Acquired on the Phoenix ICON; pediatric wide-field fundus photograph:
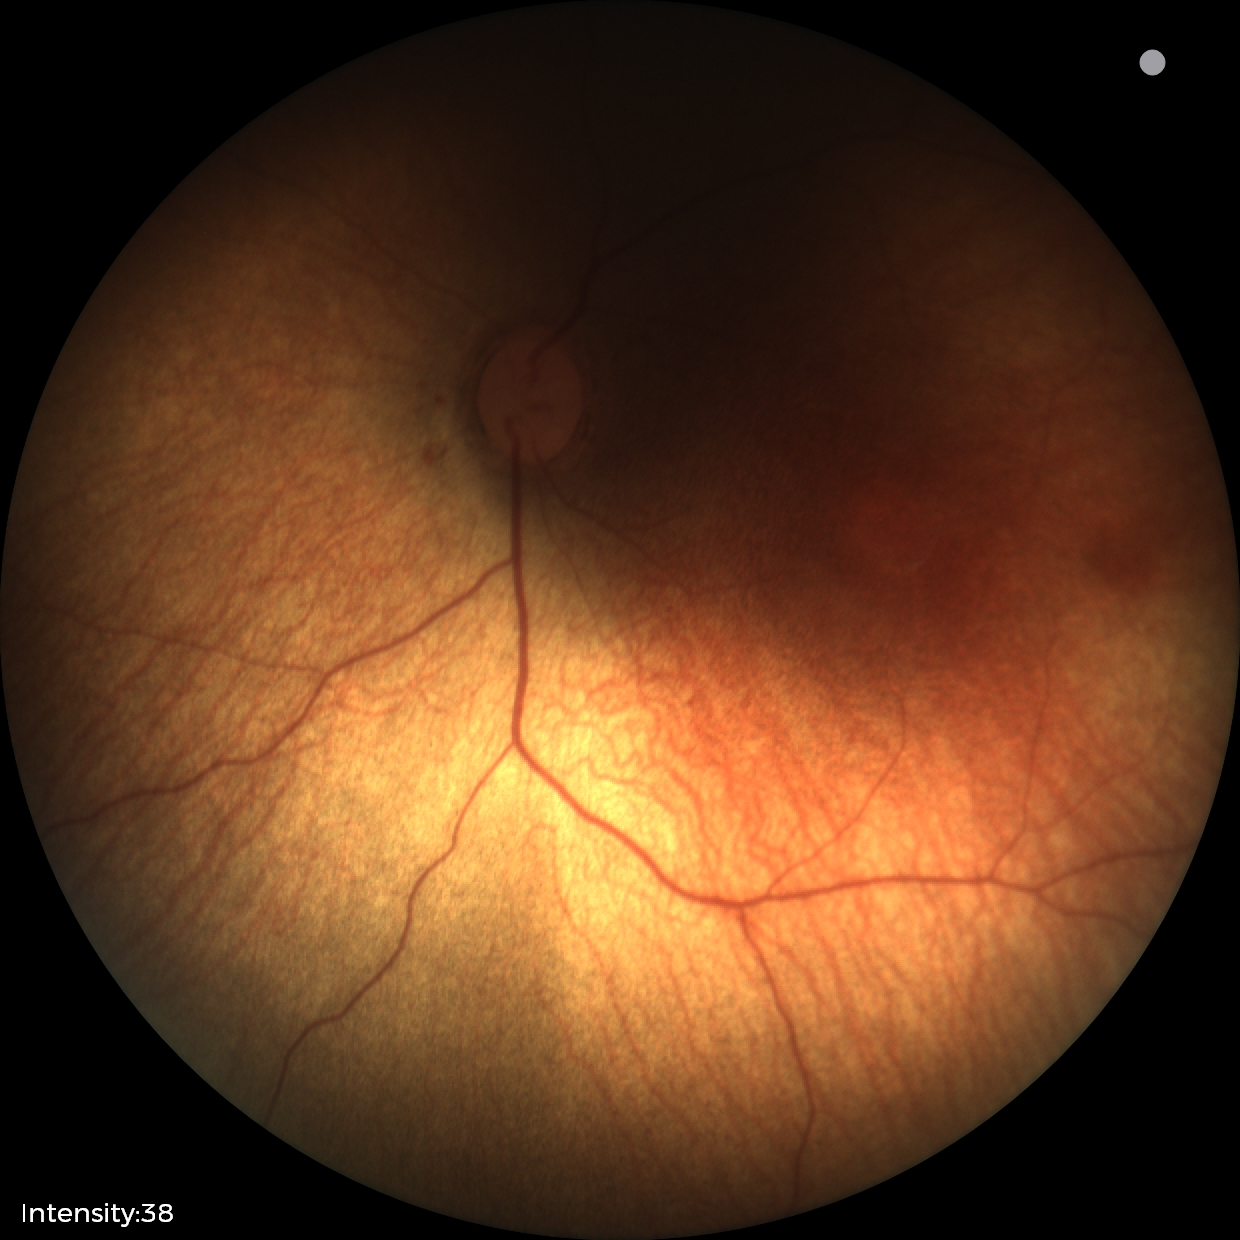
Assessment = normal.